2352x1568: 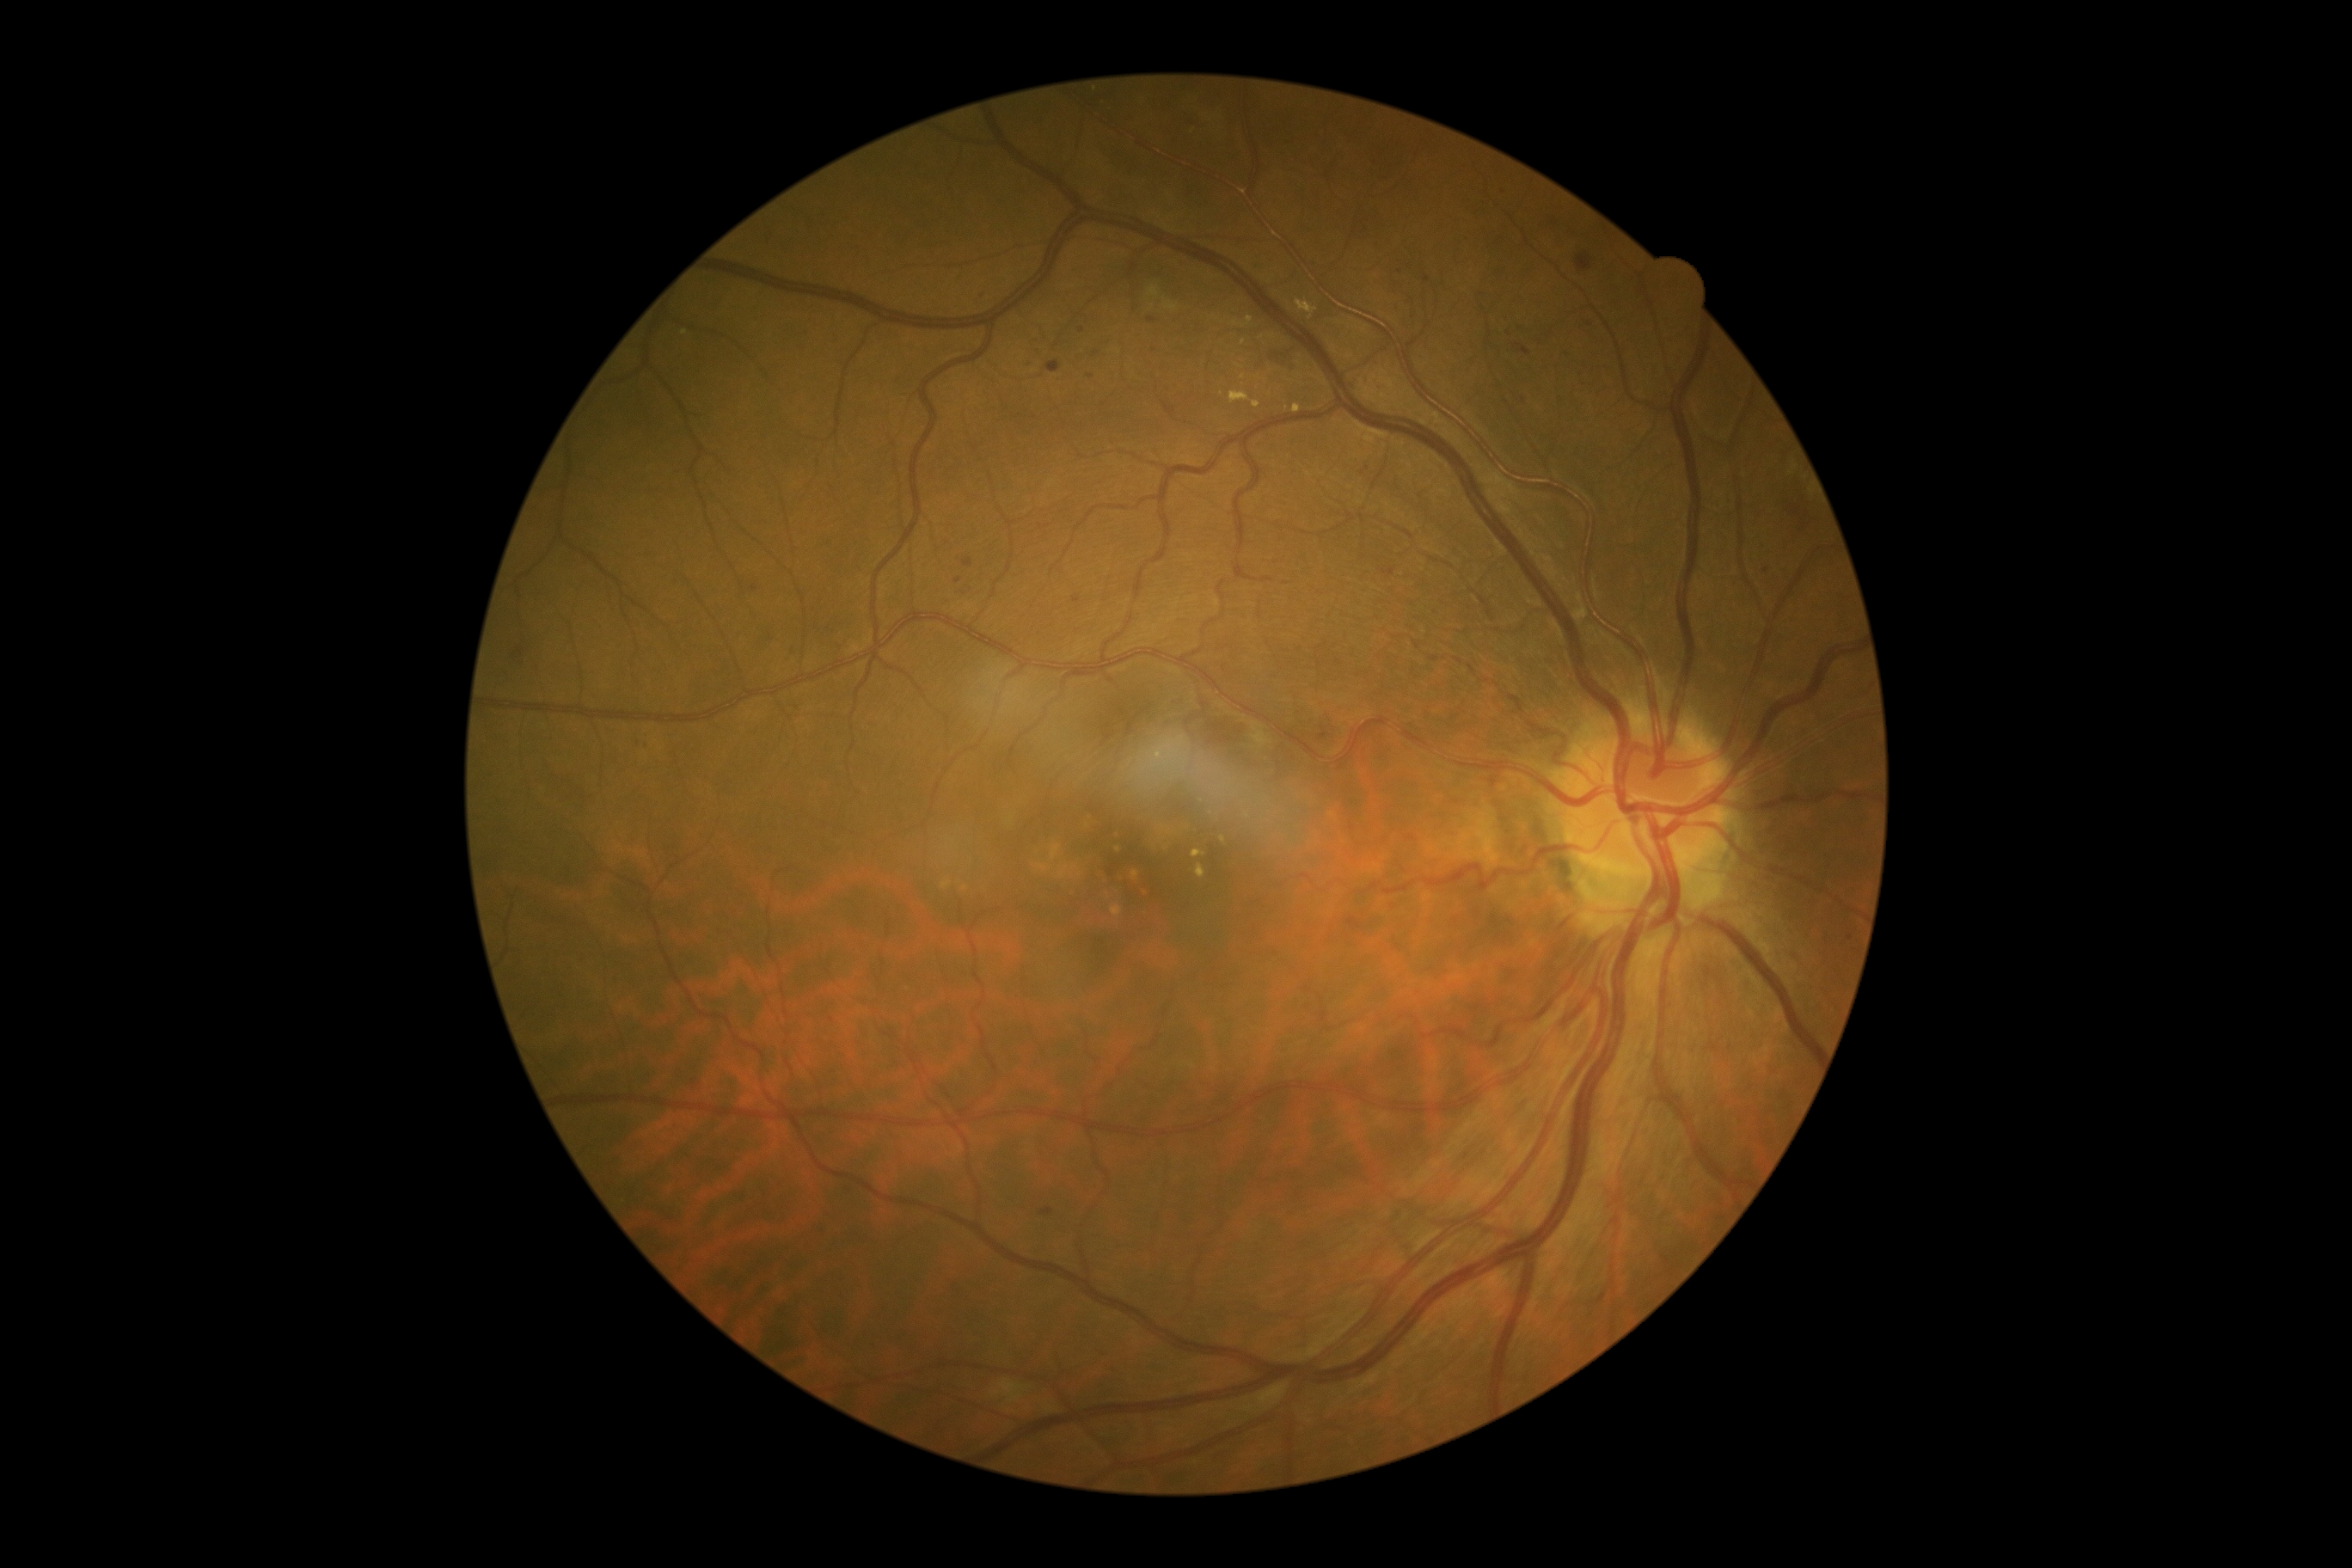

Diabetic retinopathy: 2/4.
Microaneurysms are present, including at [1039, 1208, 1053, 1218] | [964, 558, 972, 568] | [1514, 345, 1531, 355] | [1148, 317, 1156, 324].
Microaneurysms (small, approximate centers) near Point(1090, 377) | Point(1509, 335) | Point(755, 588) | Point(1029, 365) | Point(1850, 937) | Point(1082, 330) | Point(1400, 272) | Point(983, 295).